Wide-field contact fundus photograph of an infant; 1240x1240:
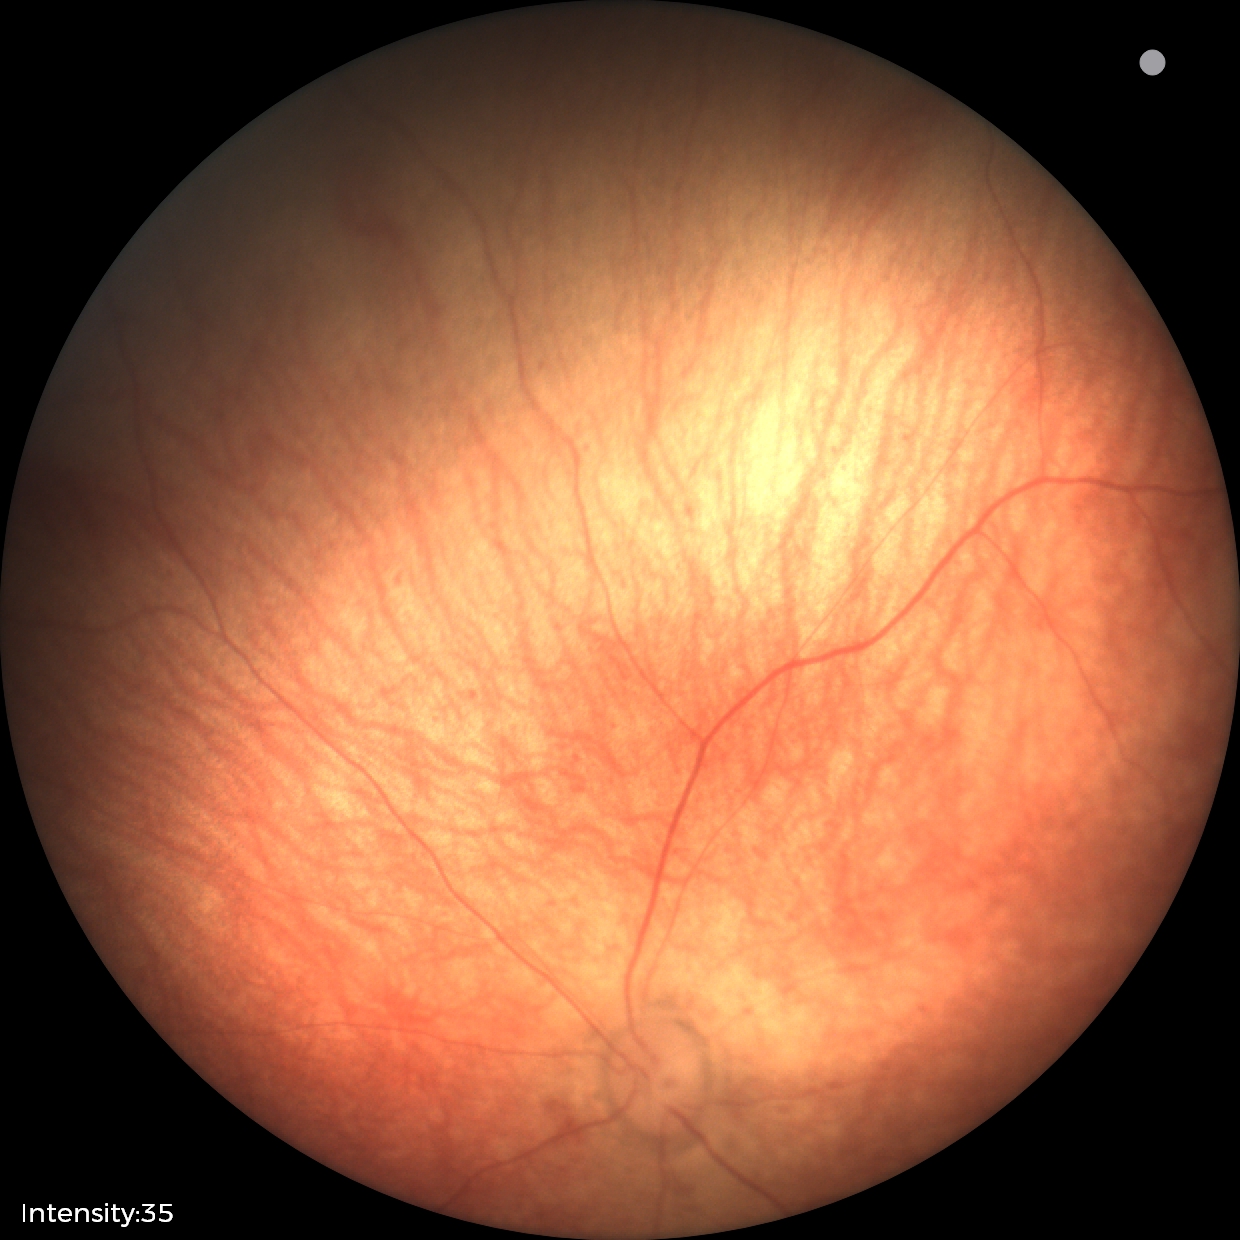 Screening examination diagnosed as physiological.